FOV: 45 degrees · 2352 x 1568 pixels · CFP: 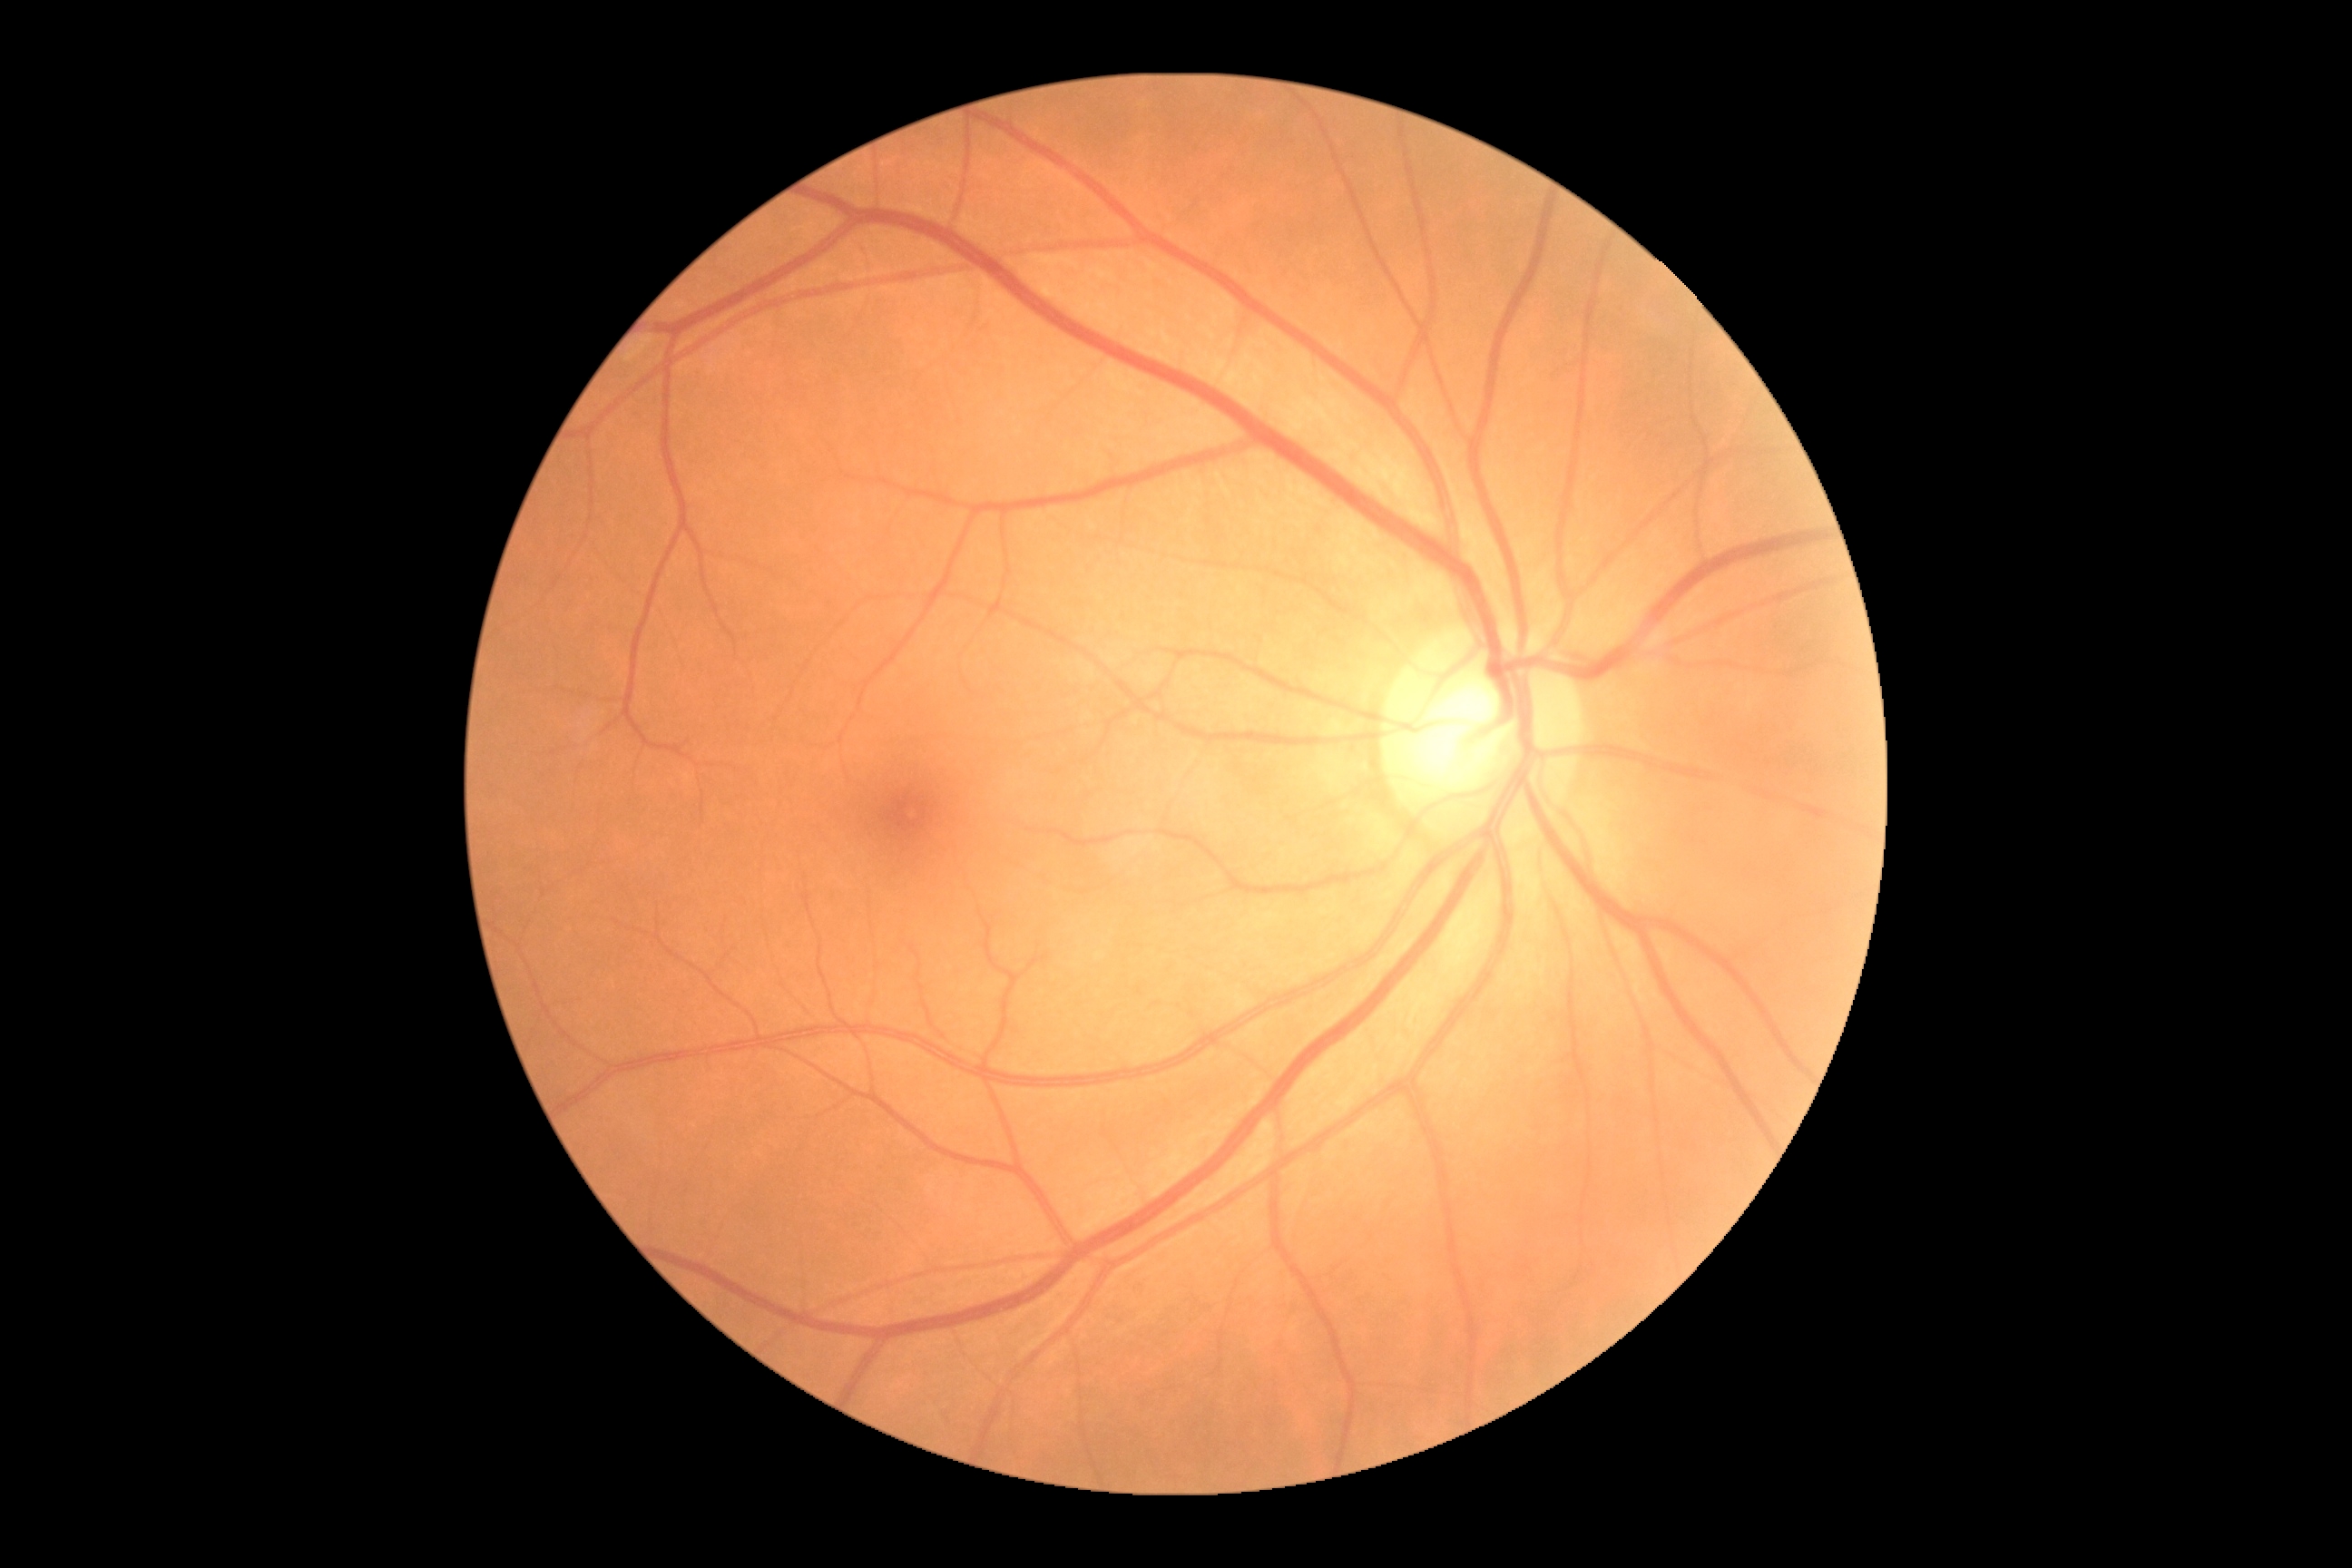

Diabetic retinopathy (DR) is no apparent diabetic retinopathy (grade 0).
No apparent diabetic retinopathy.